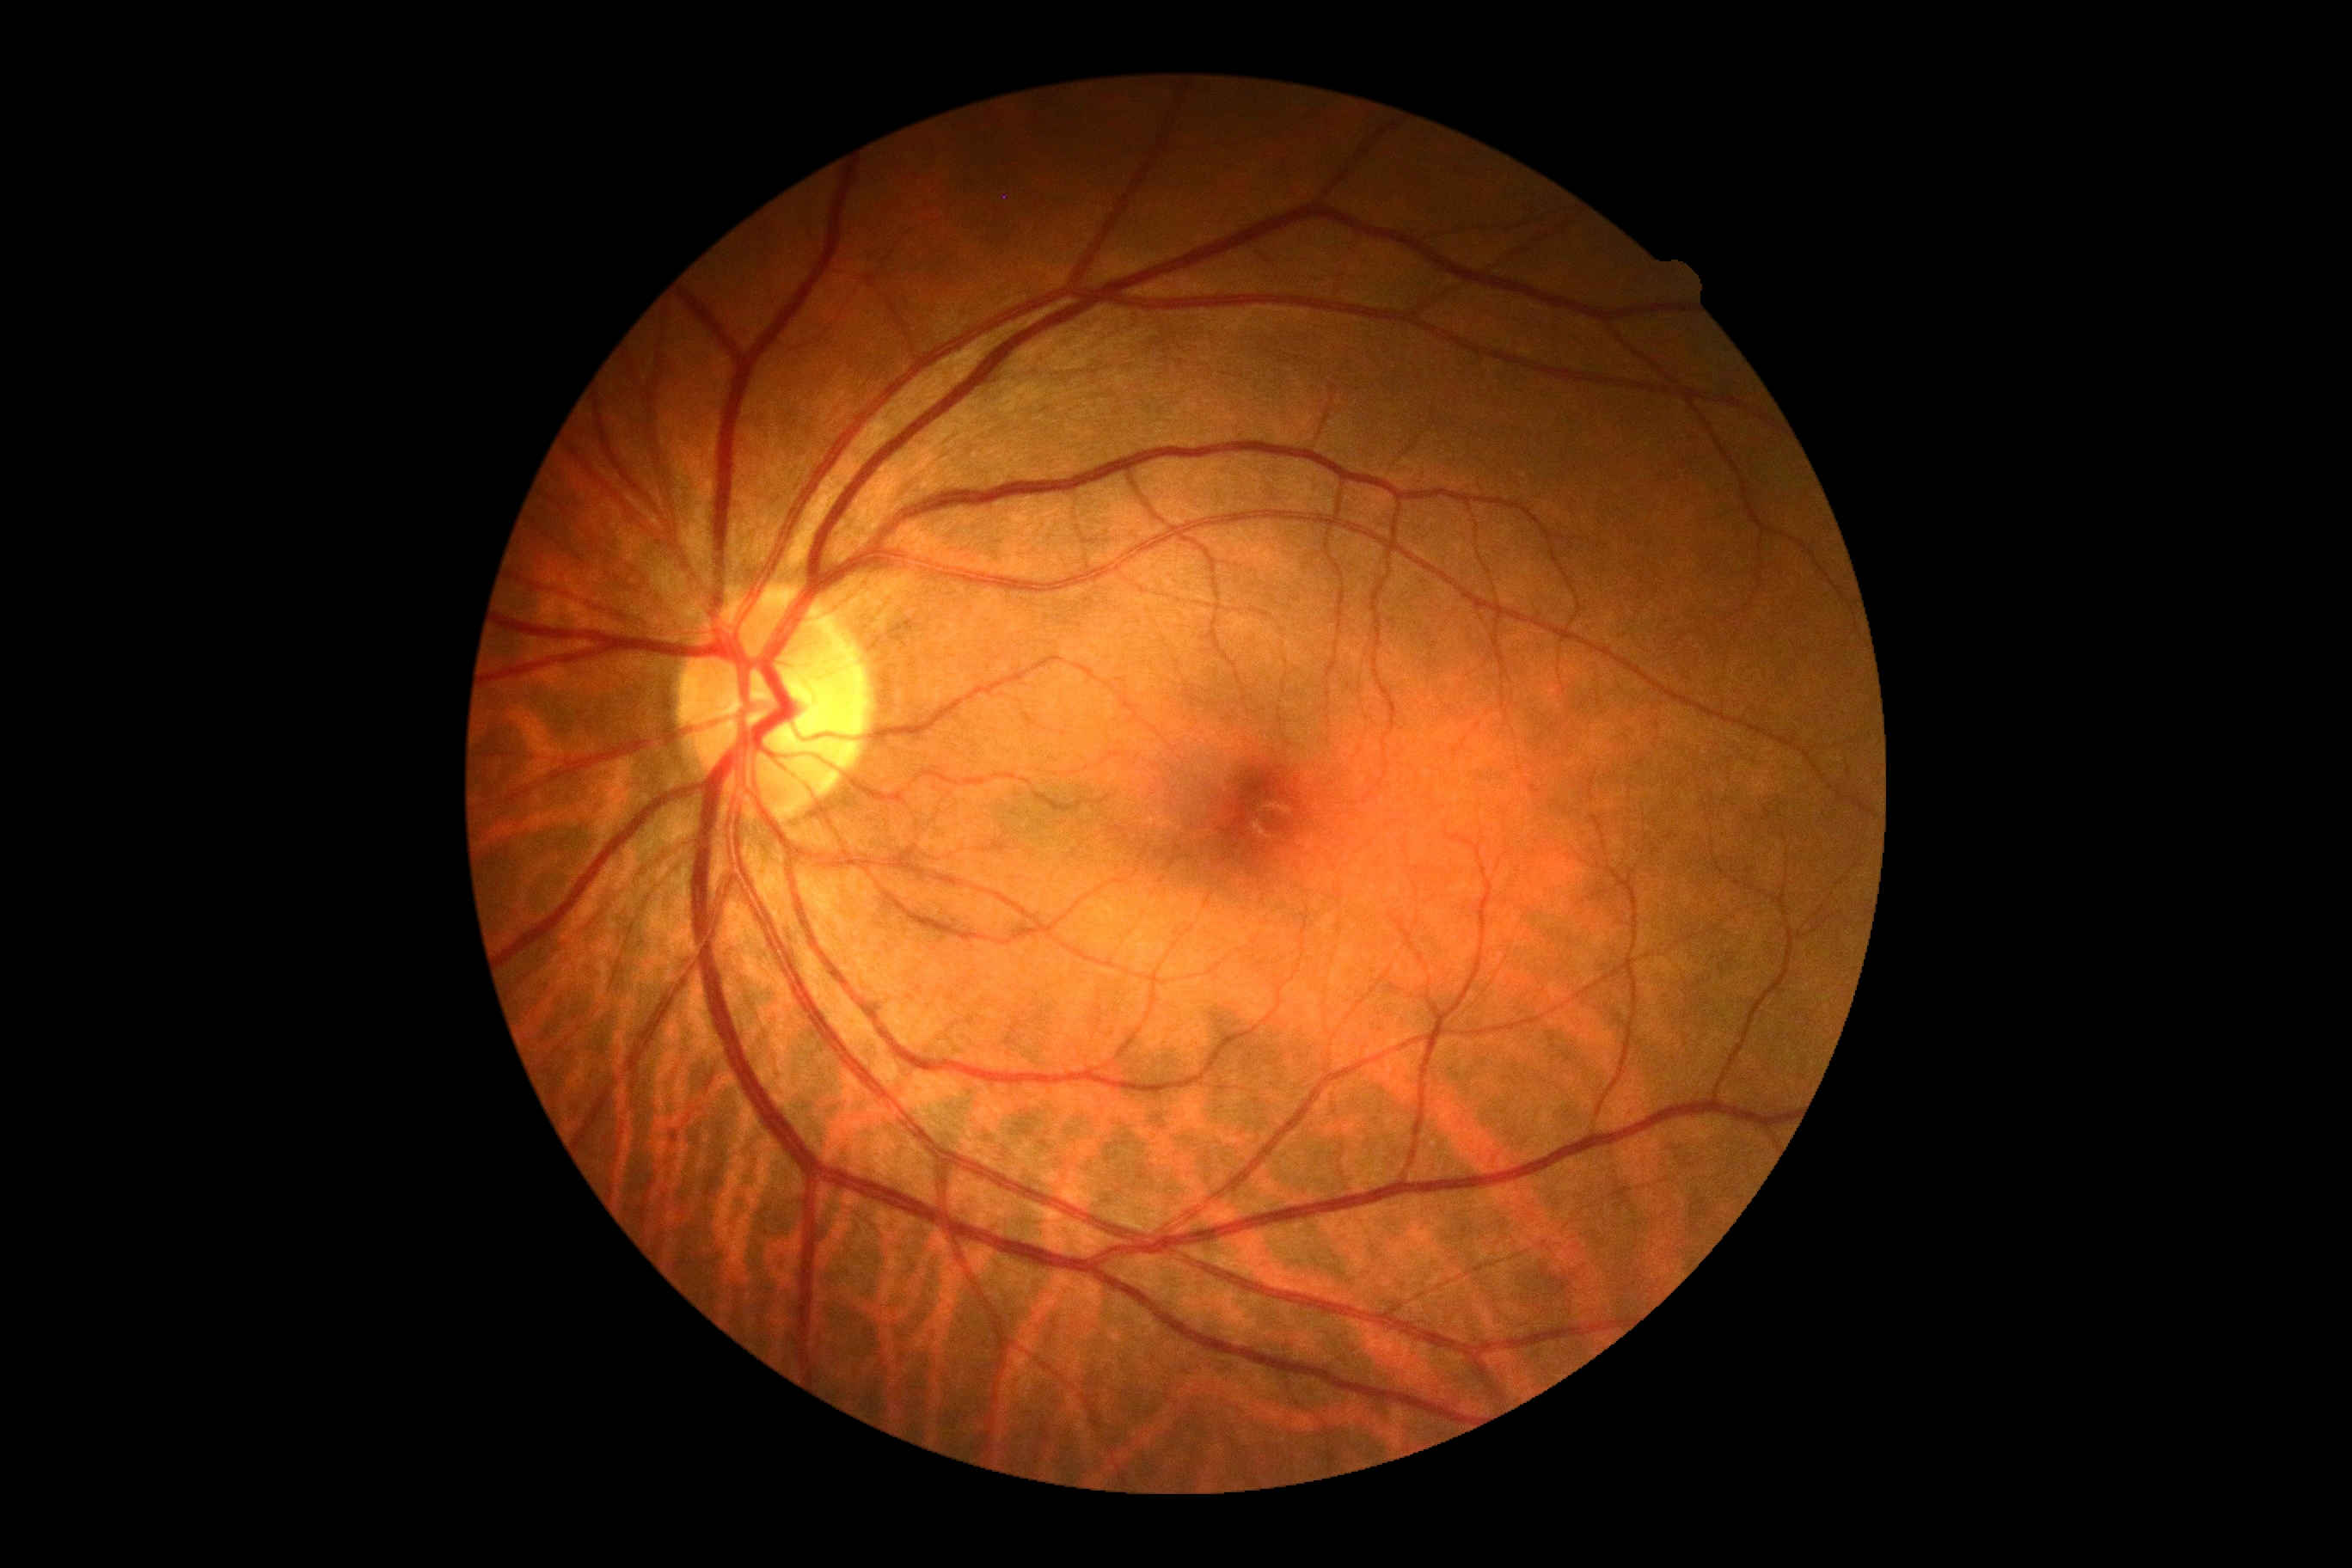

Retinopathy: grade 0 (no apparent retinopathy) — no visible signs of diabetic retinopathy.
No DR findings.